Retinal fundus photograph, 2048x1536, 45° FOV:
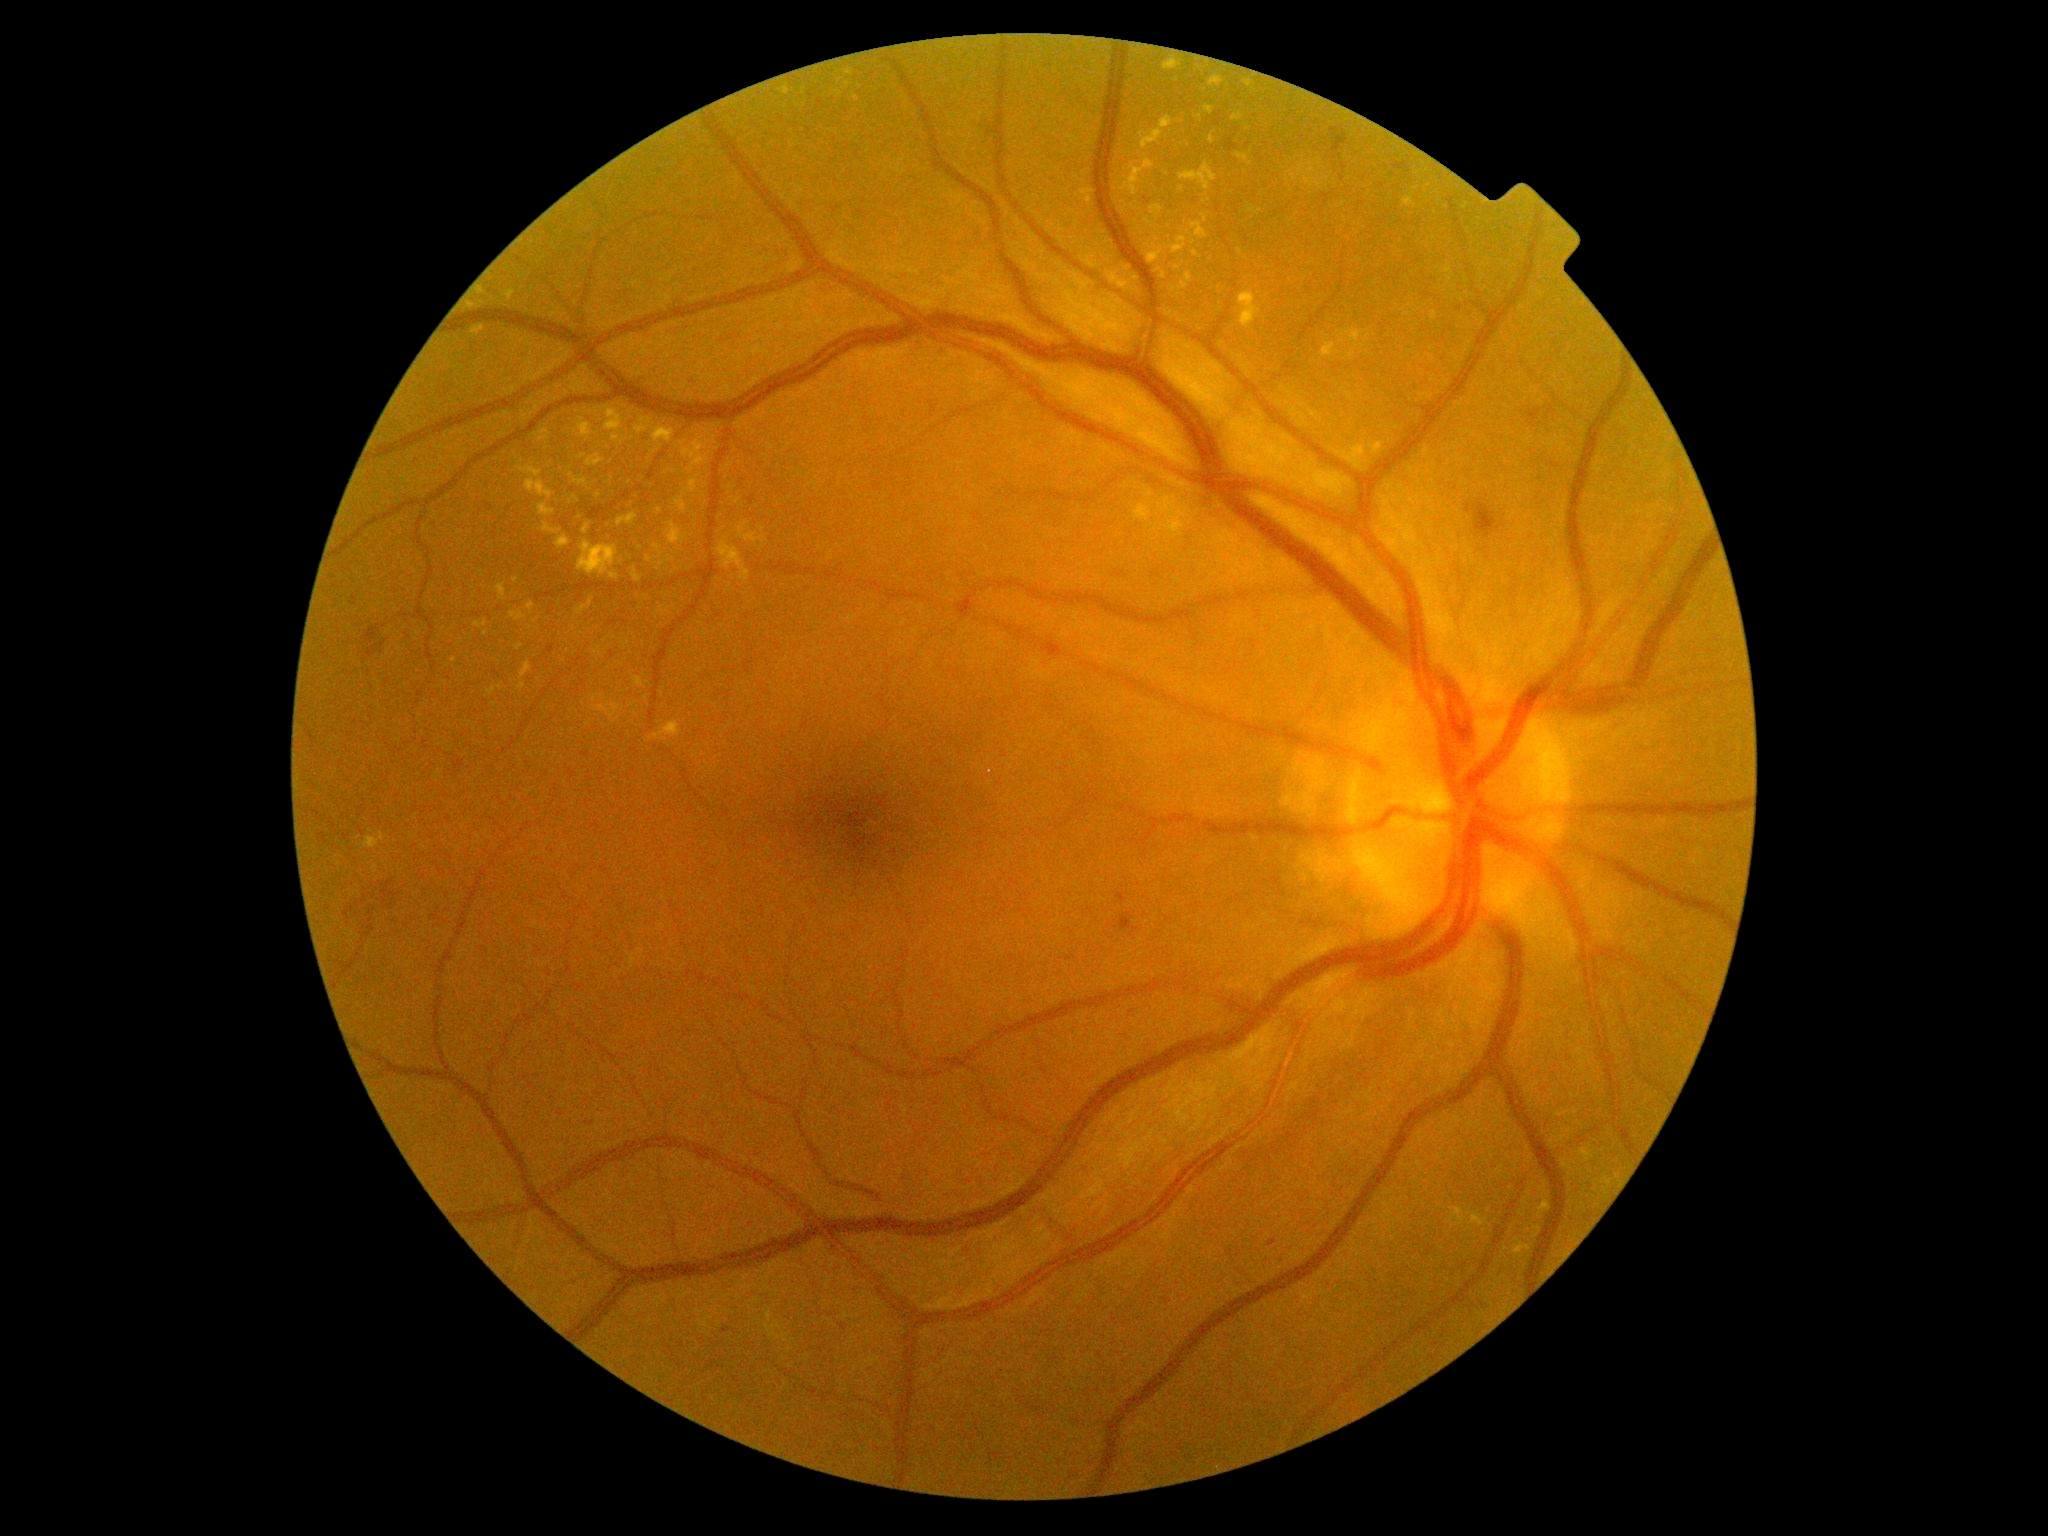
DR severity is moderate NPDR (grade 2) — more than just microaneurysms but less than severe NPDR
Representative lesions:
EXs (subset): <box>622,641,630,648</box>, <box>1205,105,1213,115</box>, <box>1156,268,1166,280</box>, <box>1145,219,1153,225</box>, <box>632,567,642,582</box>, <box>1337,445,1367,469</box>, <box>1170,237,1188,255</box>, <box>1370,442,1386,455</box>, <box>1538,1199,1552,1218</box>, <box>681,438,713,475</box>, <box>518,460,543,478</box>, <box>475,620,488,628</box>
Small EXs approximately at point(658, 569), point(530, 628), point(660, 512), point(500, 688), point(654, 452), point(1157, 240), point(1249, 130)